Acquired with a NIDEK AFC-230 — 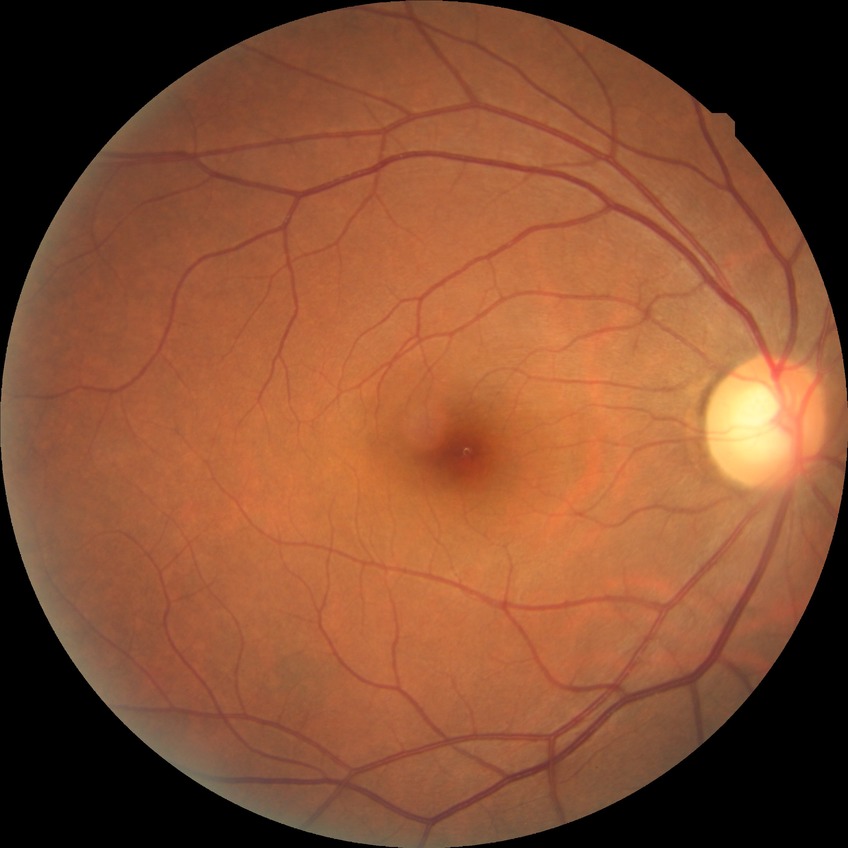 davis_grade: no diabetic retinopathy